2212x1659px — 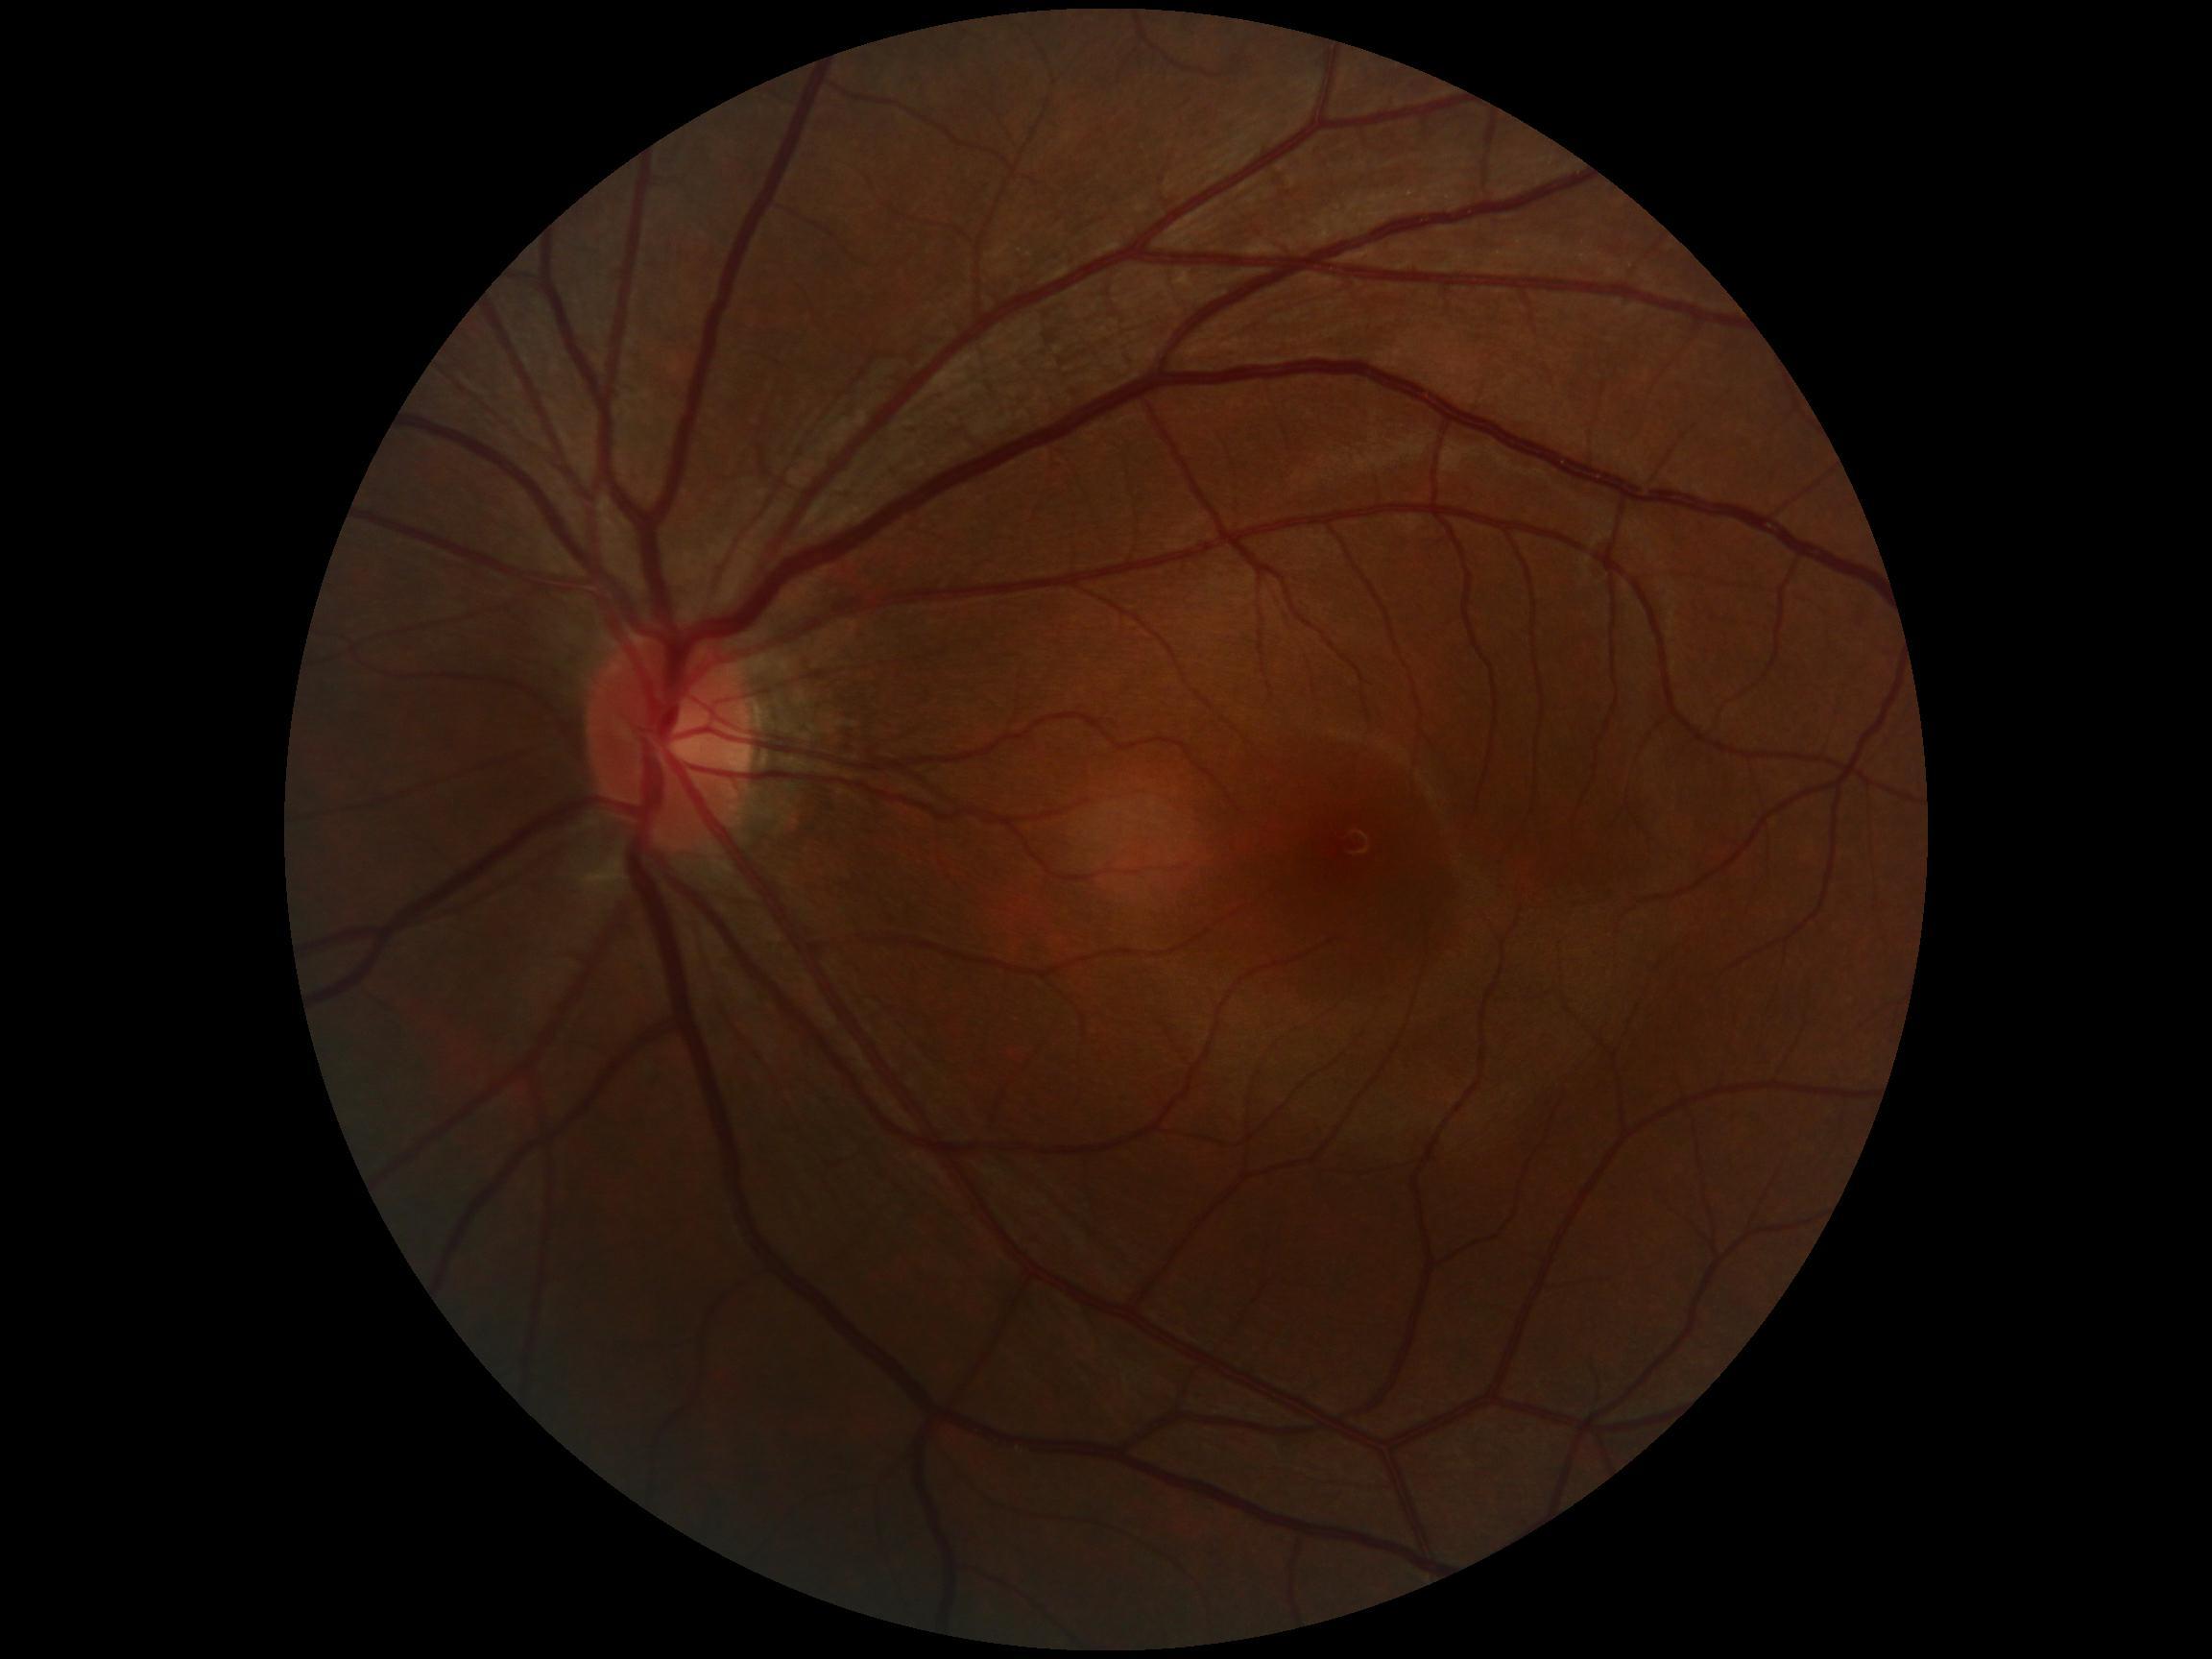

Diabetic retinopathy is 0/4. No apparent diabetic retinopathy.